45° FOV.
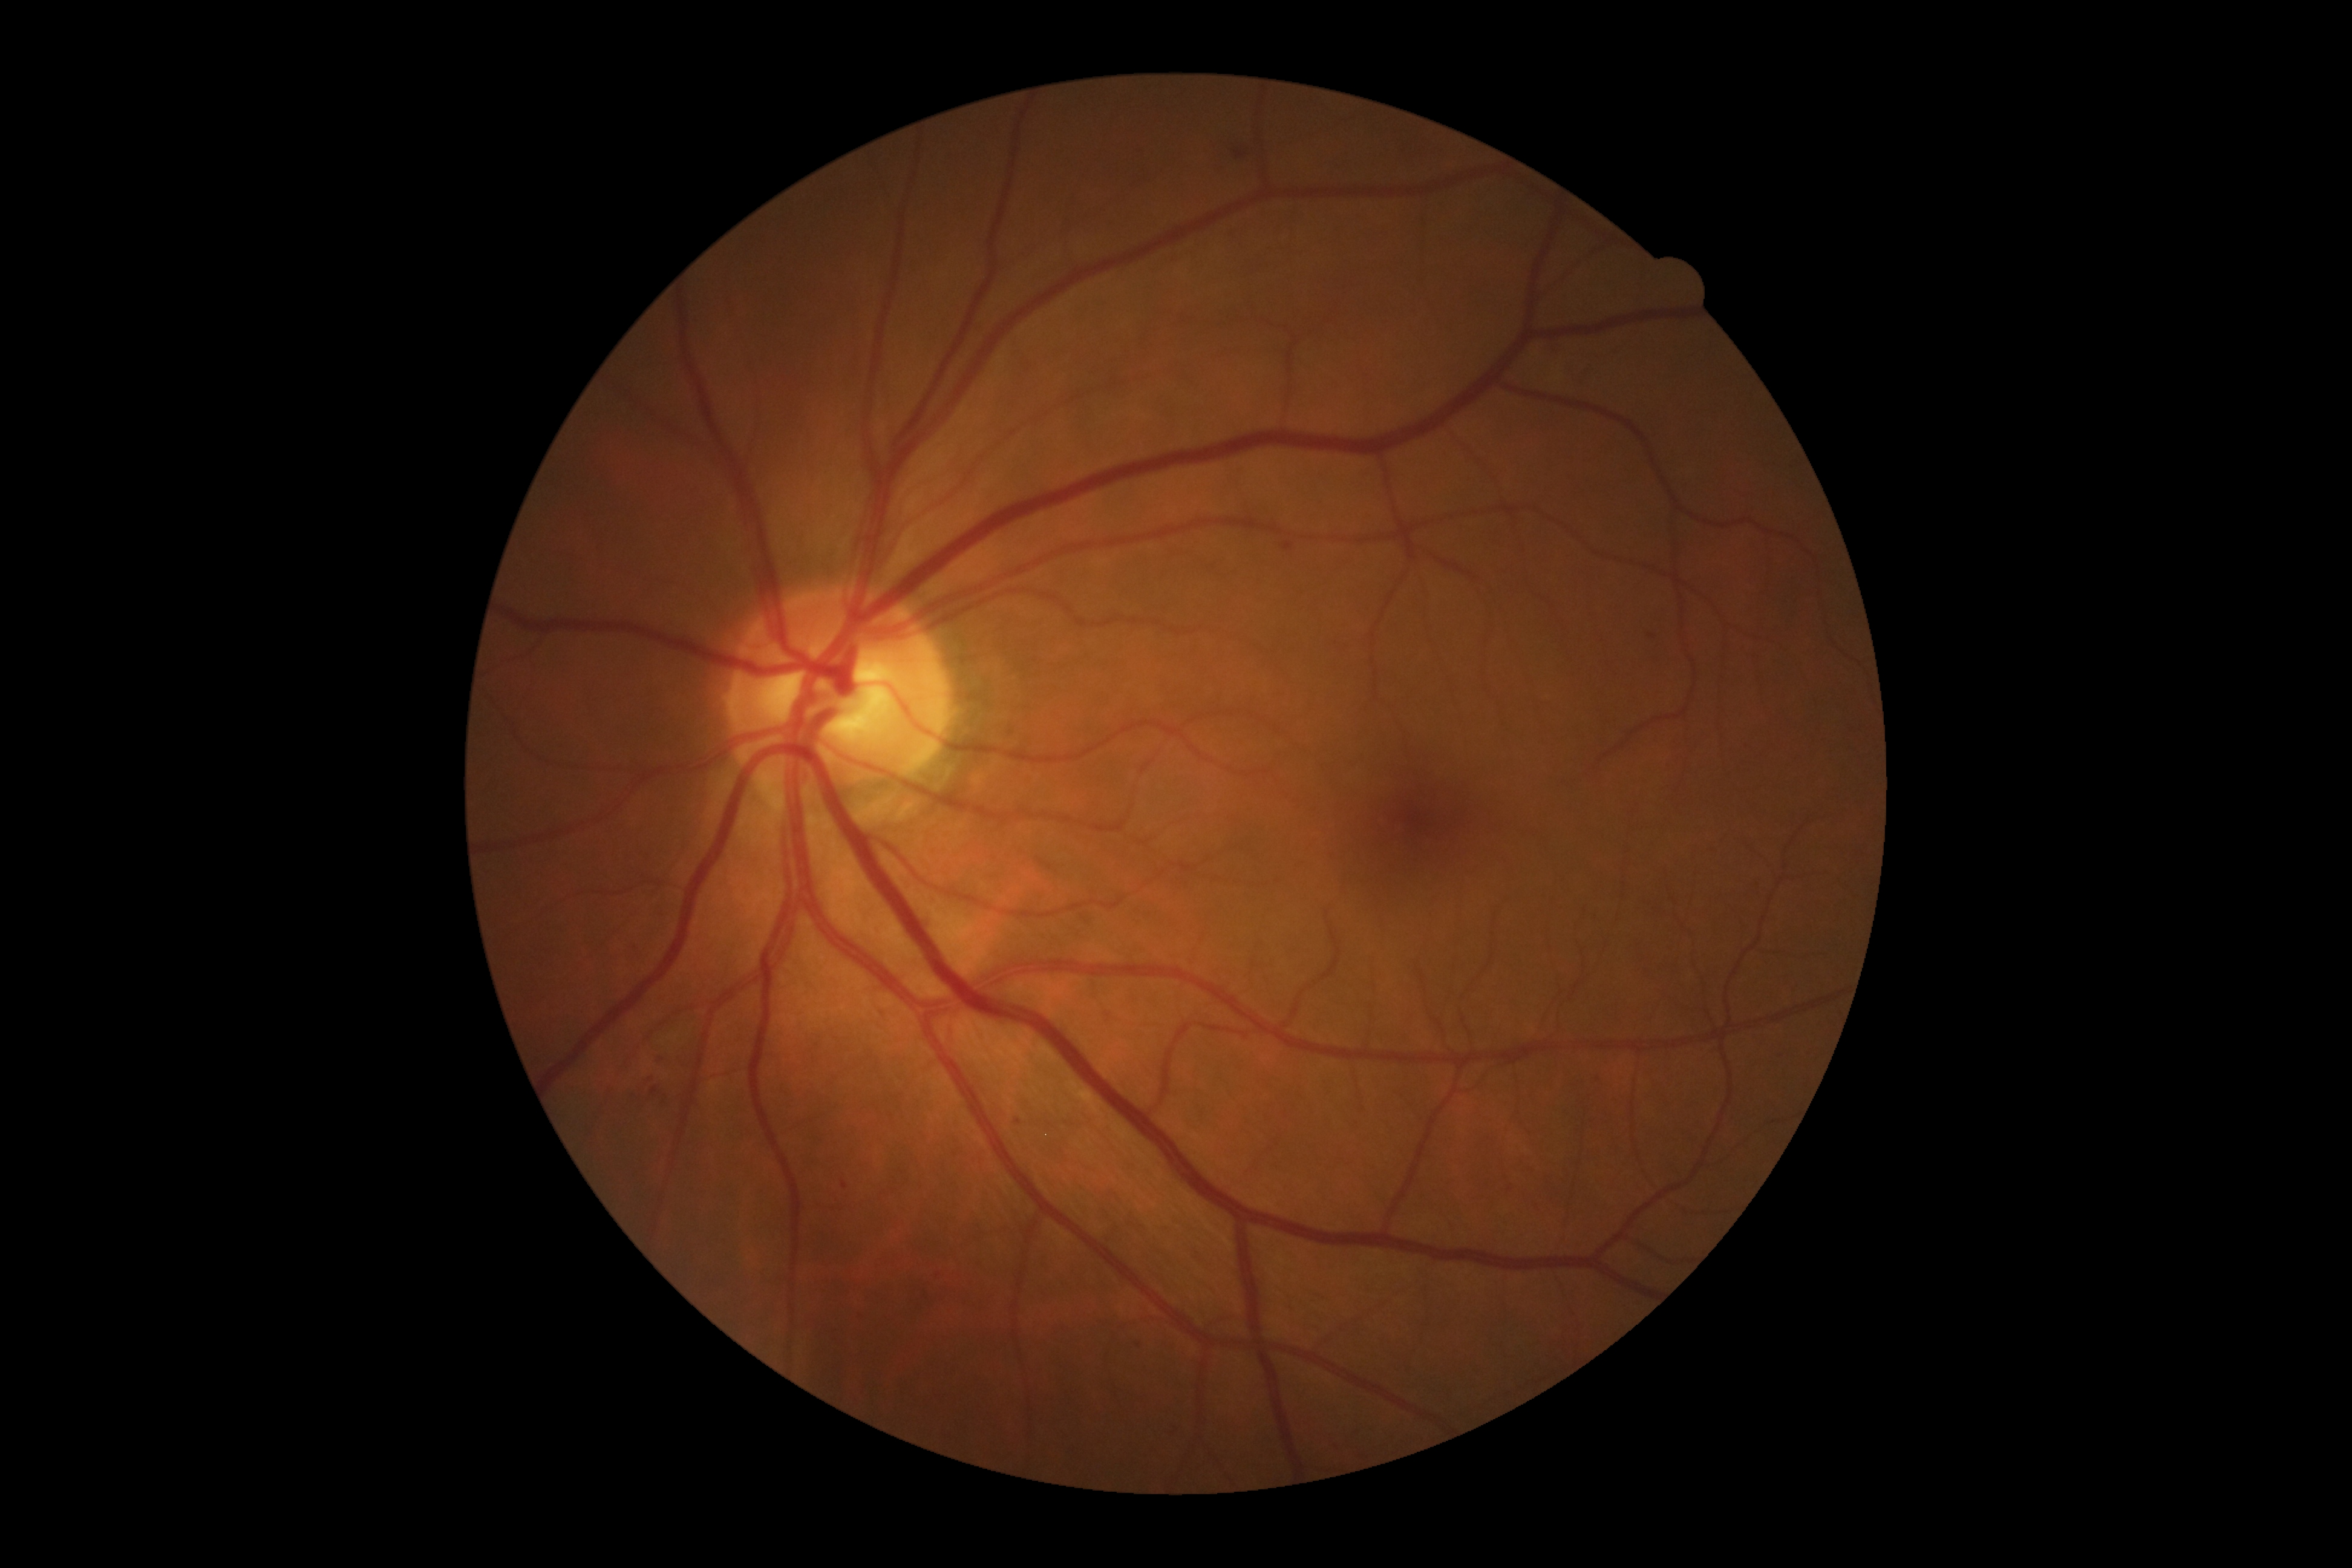
Diabetic retinopathy grade is 2.